Wide-field contact fundus photograph of an infant
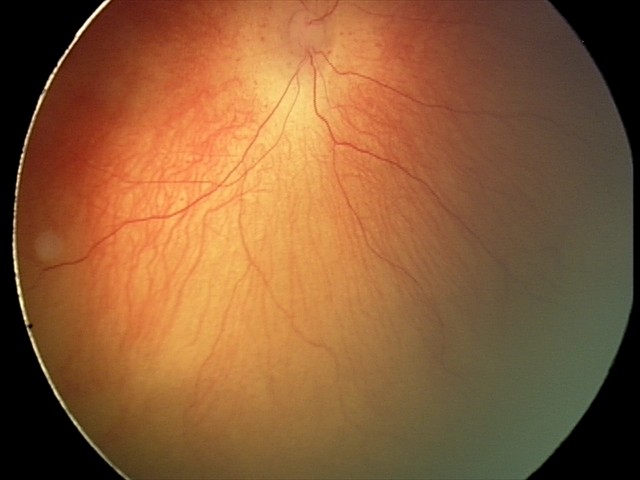
Diagnosis from this screening exam: ROP stage 2.